45-degree field of view. Color fundus photograph. Image size 1932x1910:
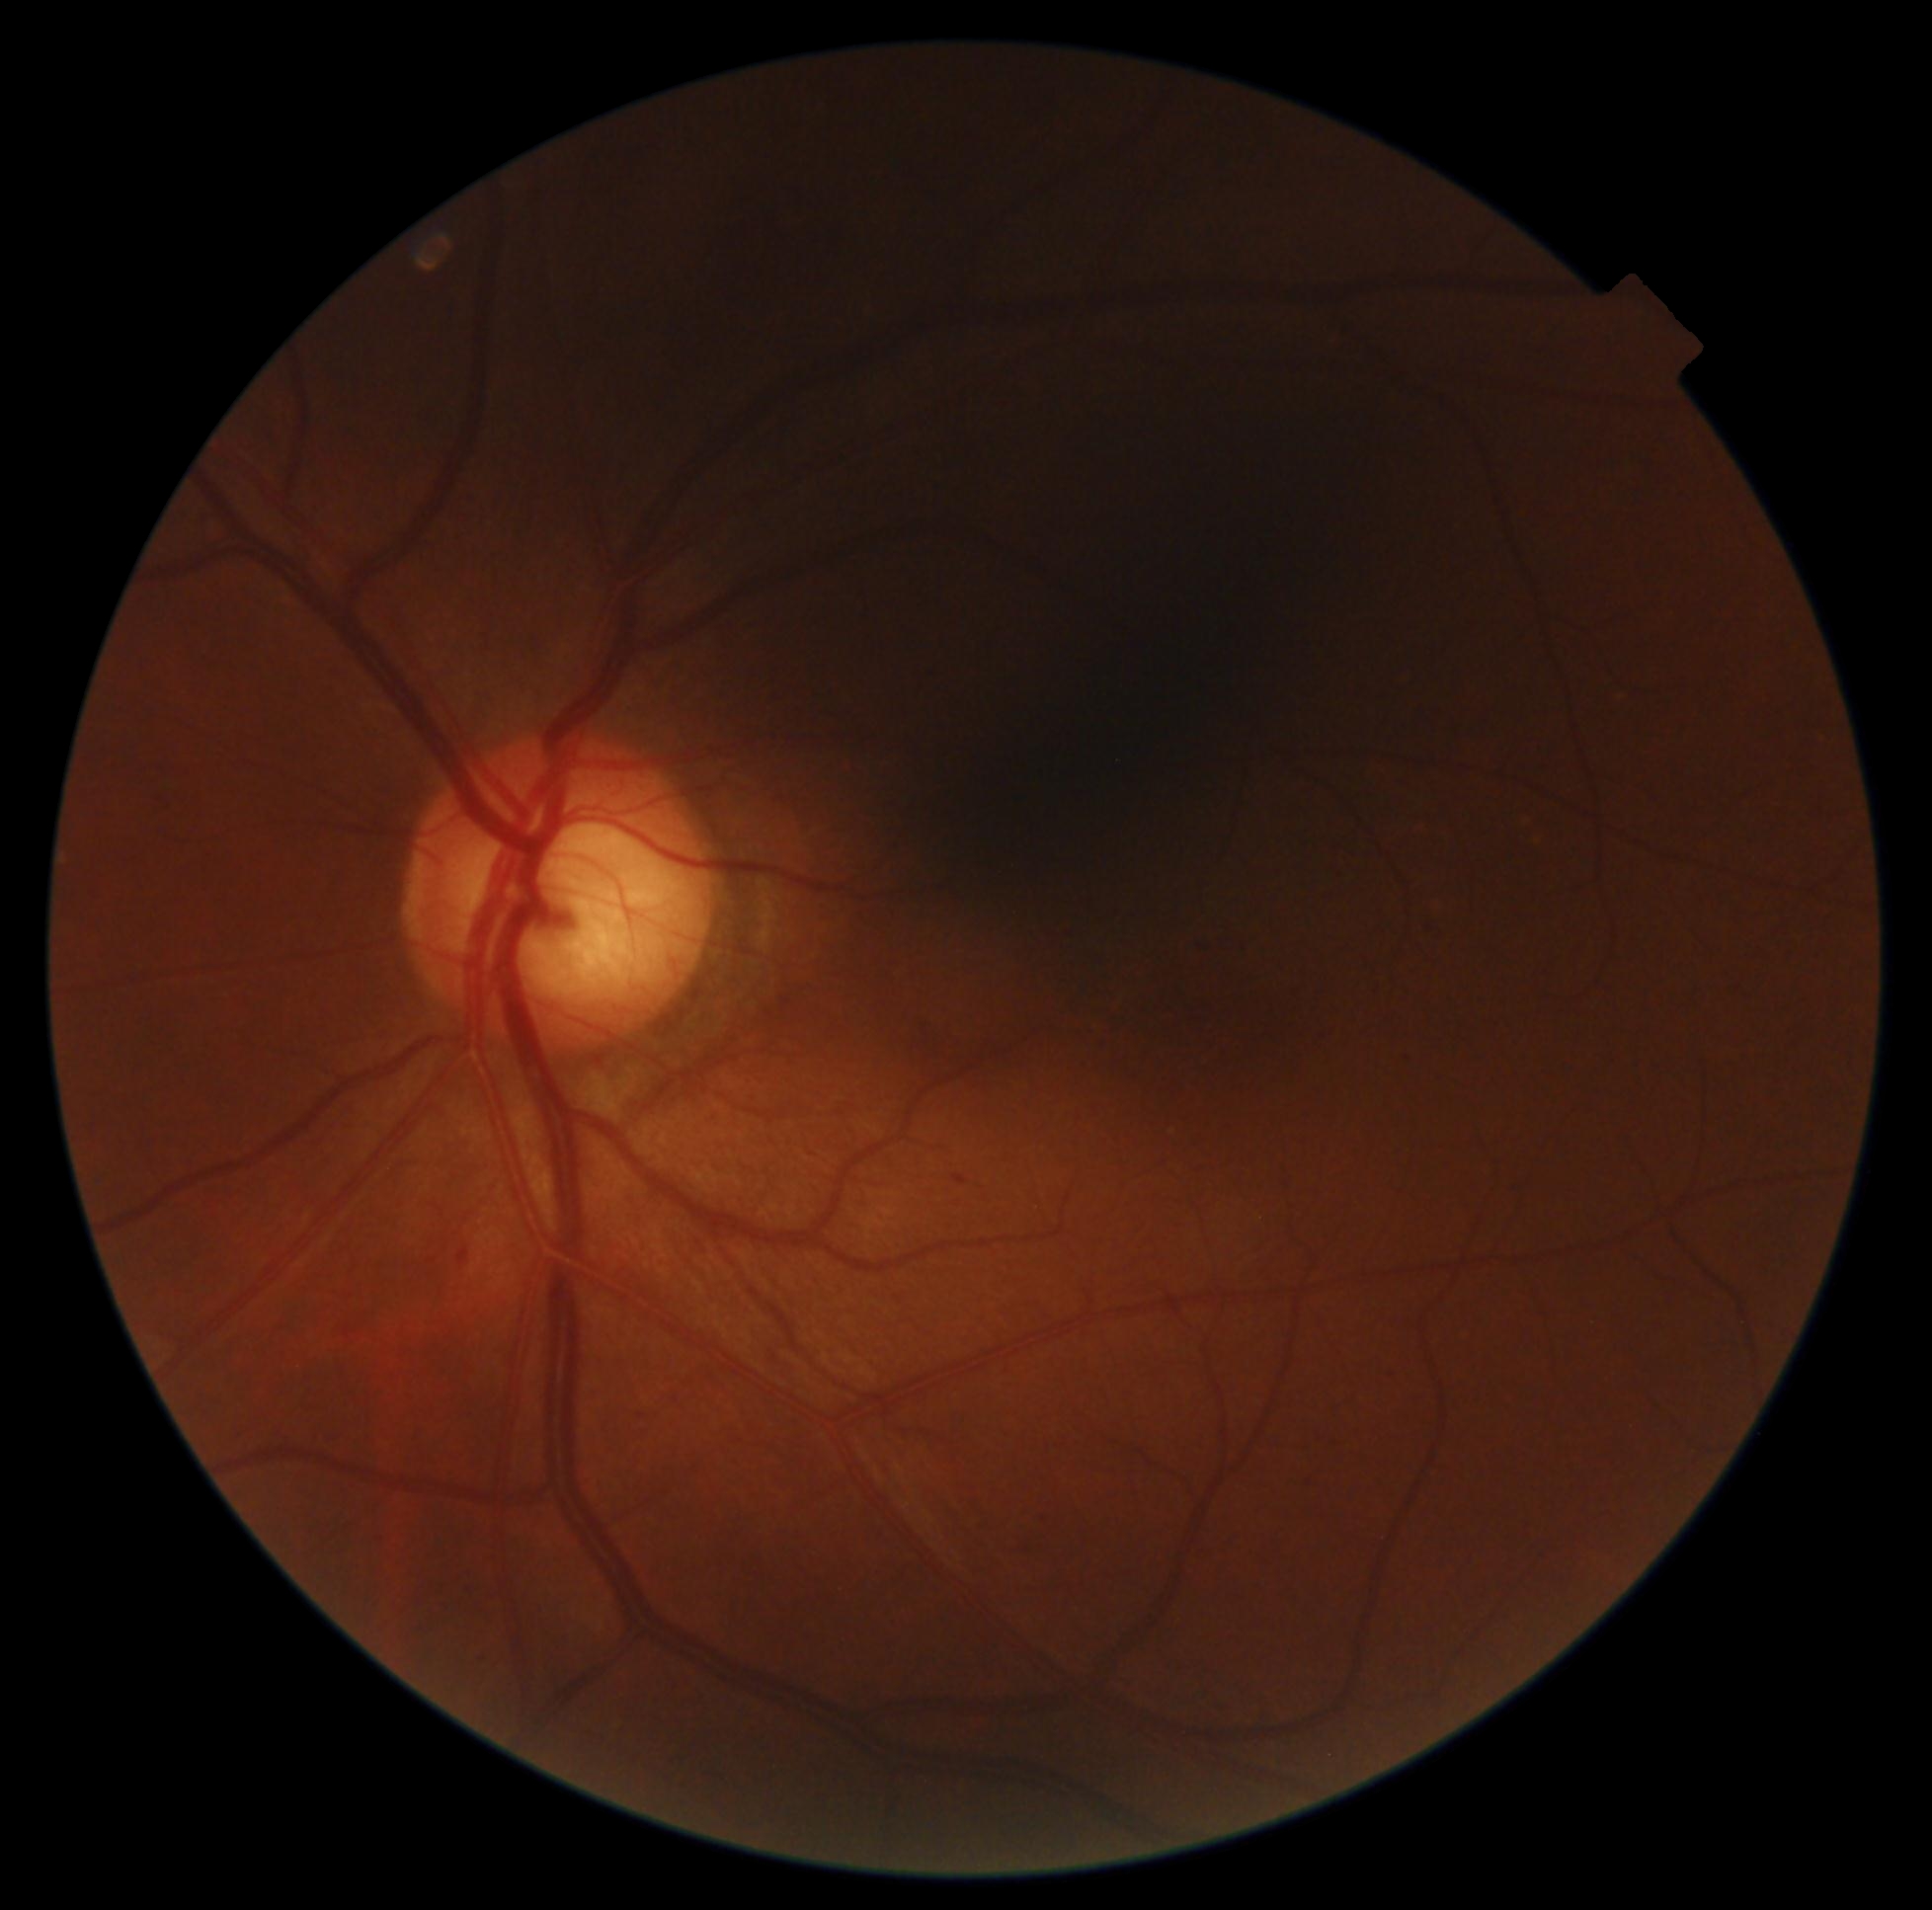

Diabetic retinopathy (DR) is grade 1 (mild NPDR).